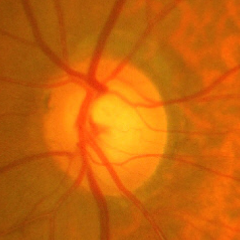

Glaucomatous optic neuropathy is present.
Early glaucomatous optic neuropathy.